Pediatric wide-field fundus photograph — 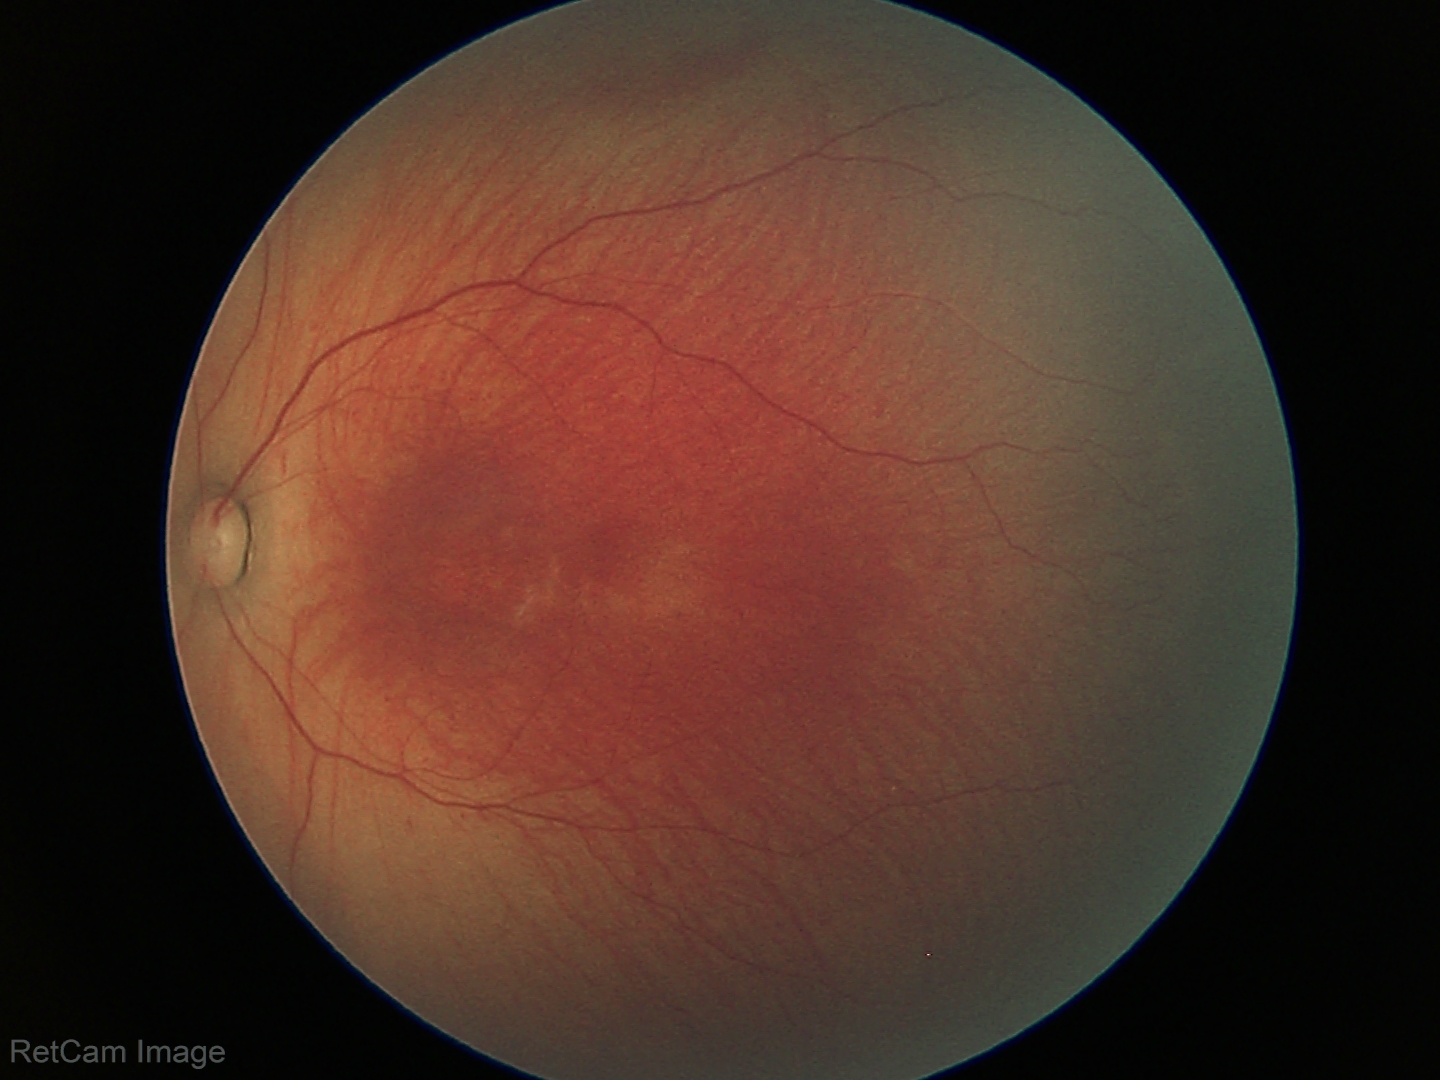 Screening diagnosis: retinopathy of prematurity stage 1; no plus disease.